2228x1652 · 50-degree field of view · captured after pupil dilation · posterior pole field covering the optic disc and macula · retinal fundus photograph: 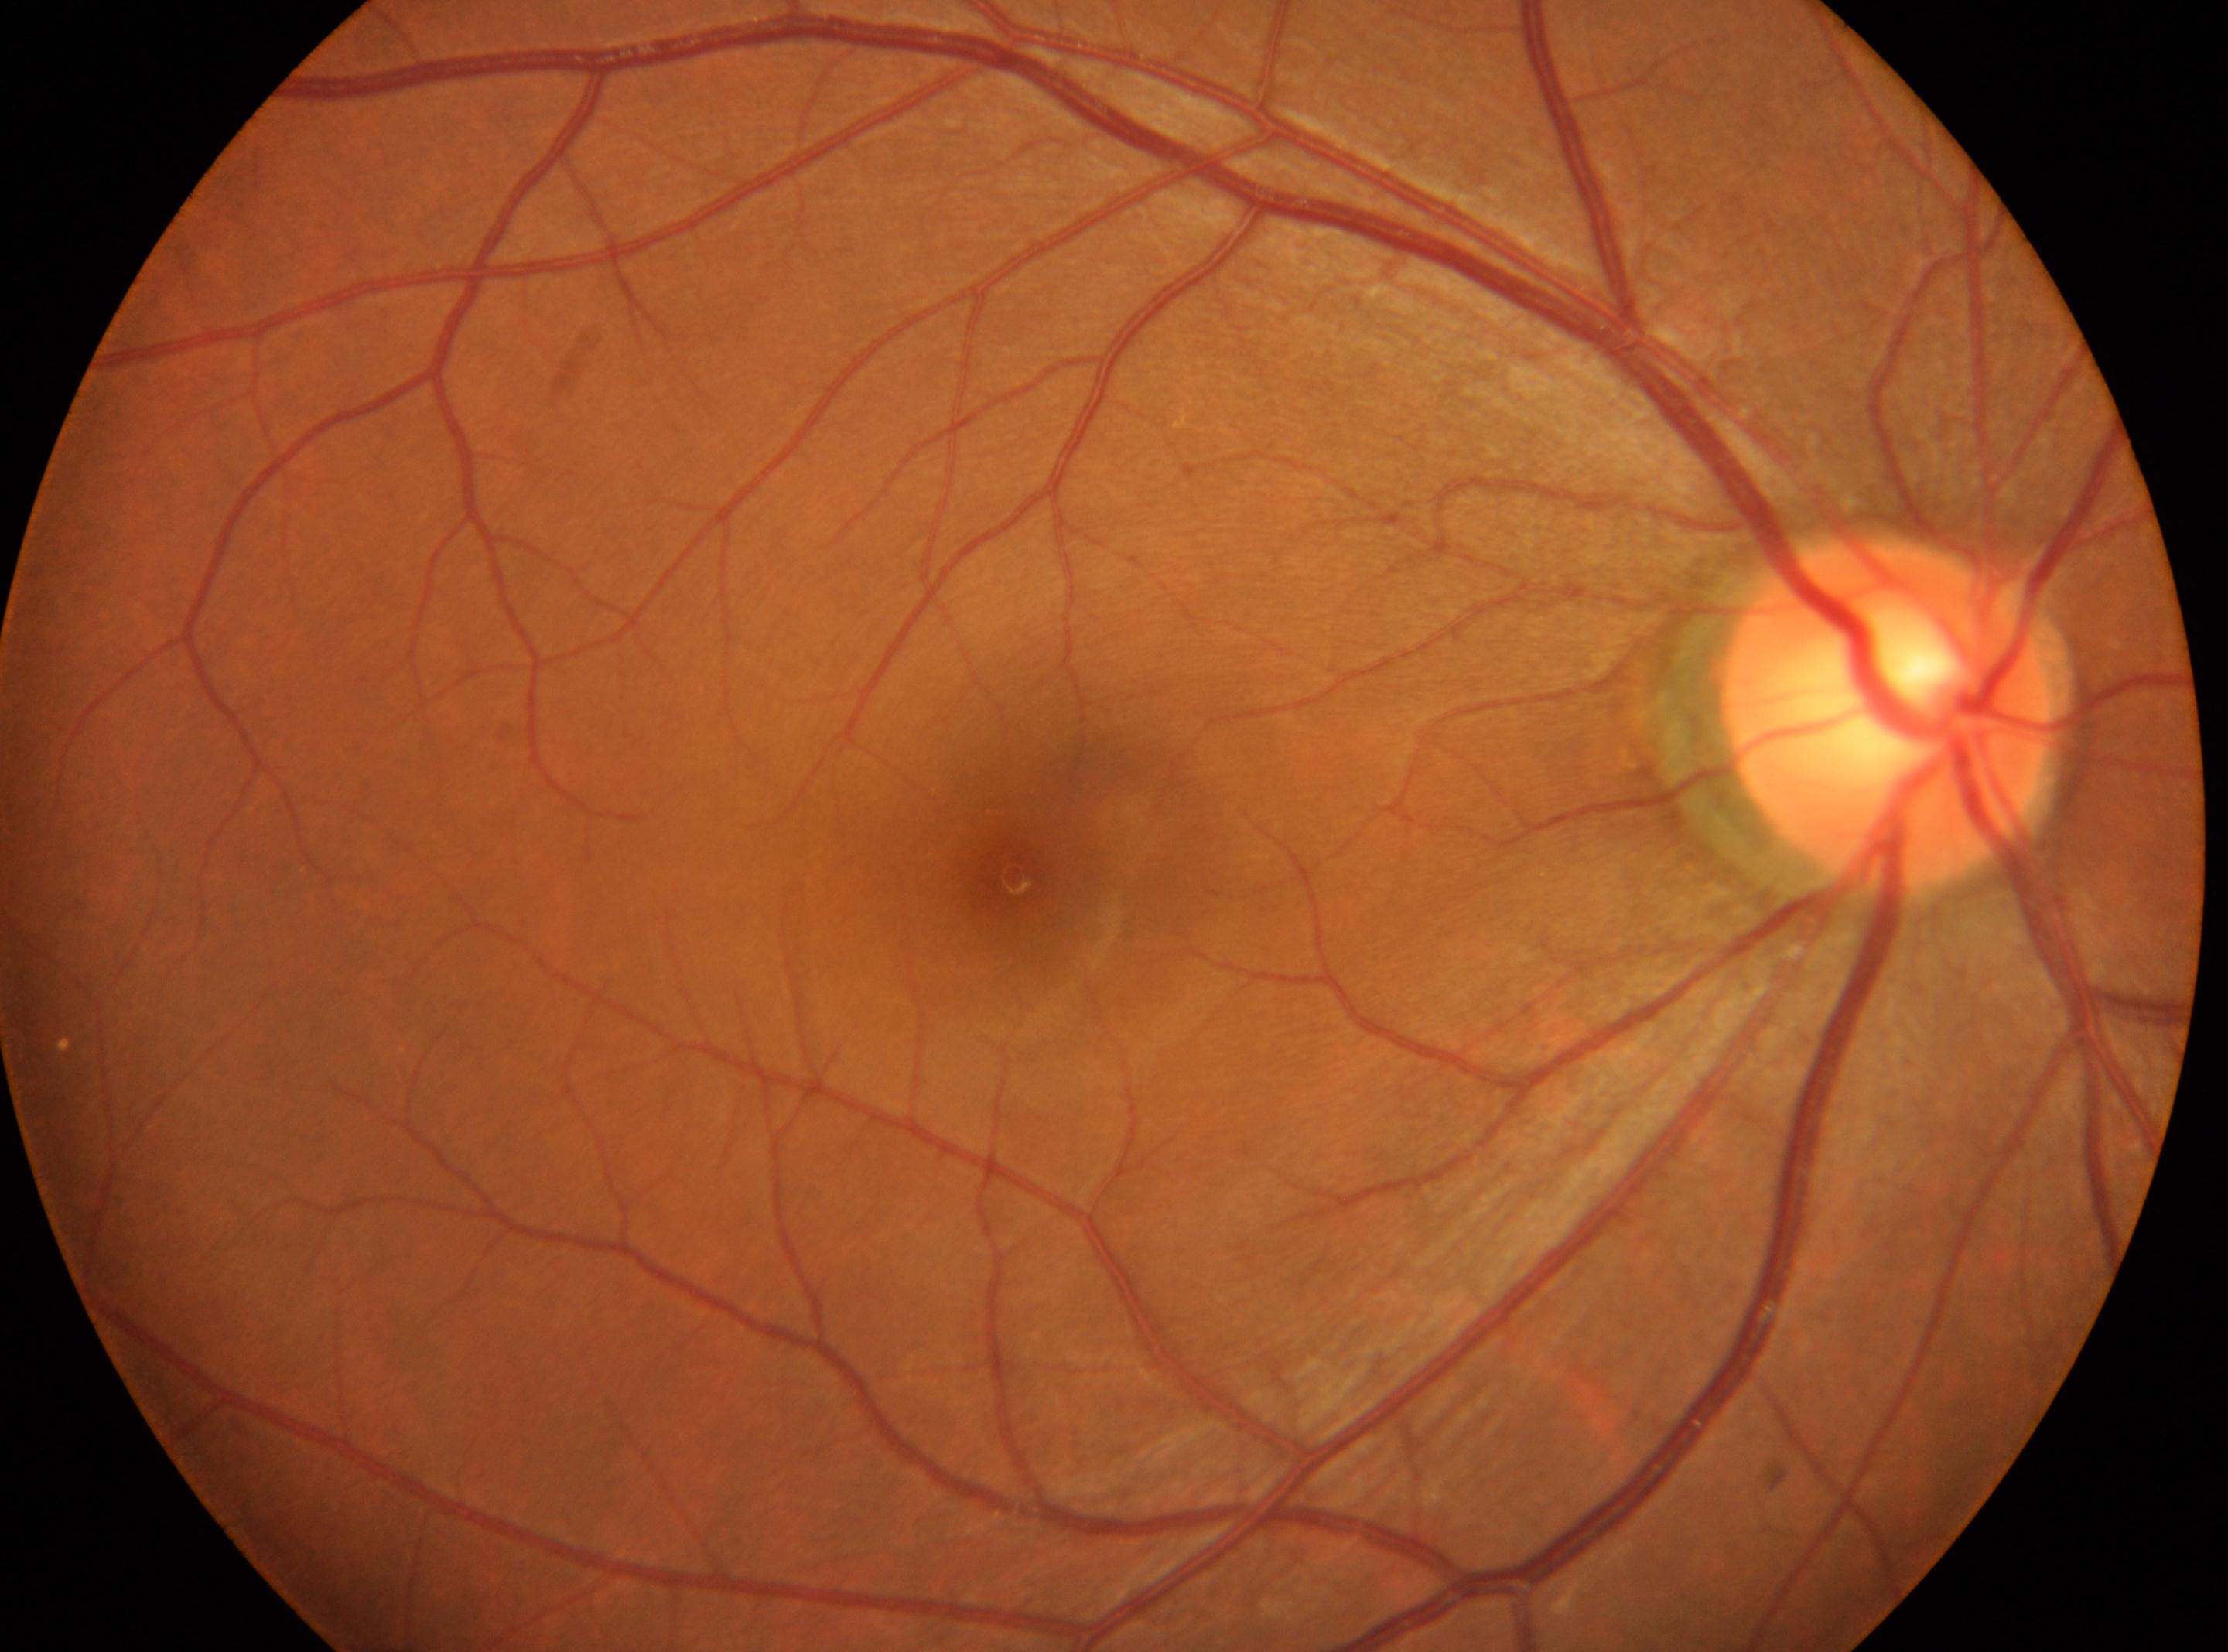
Optic disc center: x=1886, y=715. No diabetic retinal disease findings. Diabetic retinopathy: 0/4. Eye: right eye. Fovea: x=1012, y=877.